848 x 848 pixels, Davis DR grading — 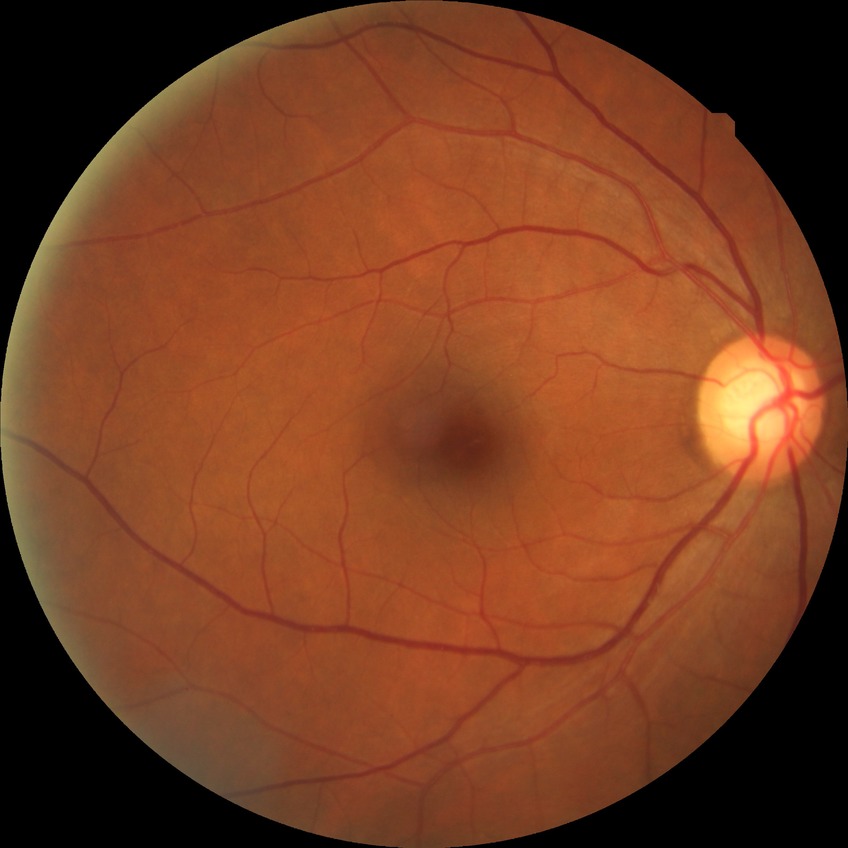

modified Davis classification=no diabetic retinopathy.